CFP. 45° FOV.
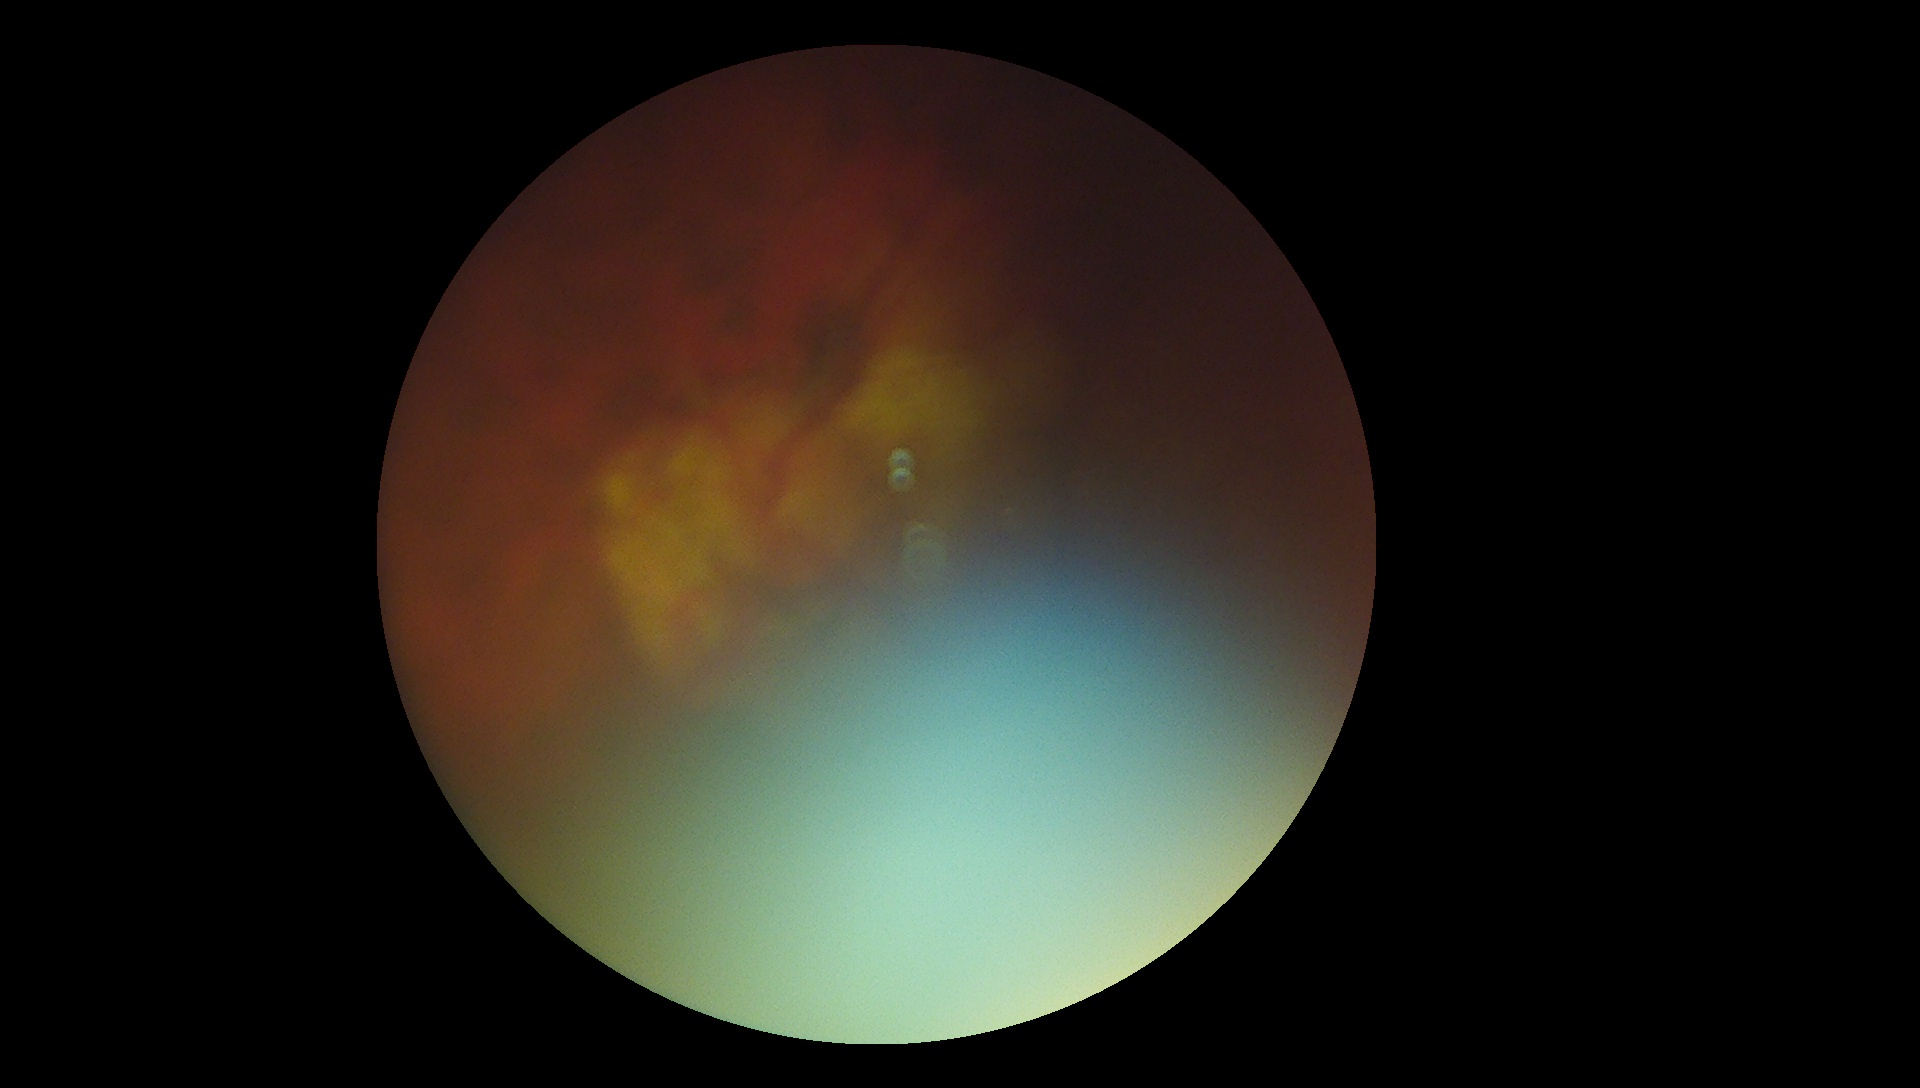

Retinopathy grade is ungradable due to poor image quality. The image cannot be graded for diabetic retinopathy.